Modified Davis classification, 848 by 848 pixels, FOV: 45 degrees, posterior pole color fundus photograph, NIDEK AFC-230:
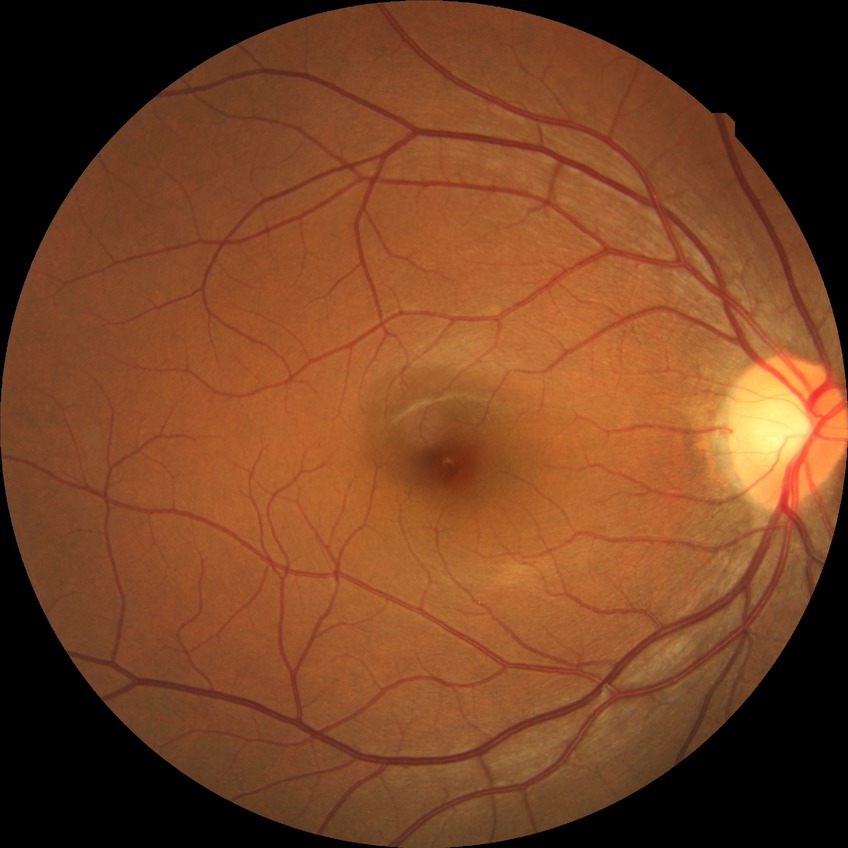 Diabetic retinopathy (DR): no diabetic retinopathy (NDR).